Wide-field fundus photograph from neonatal ROP screening:
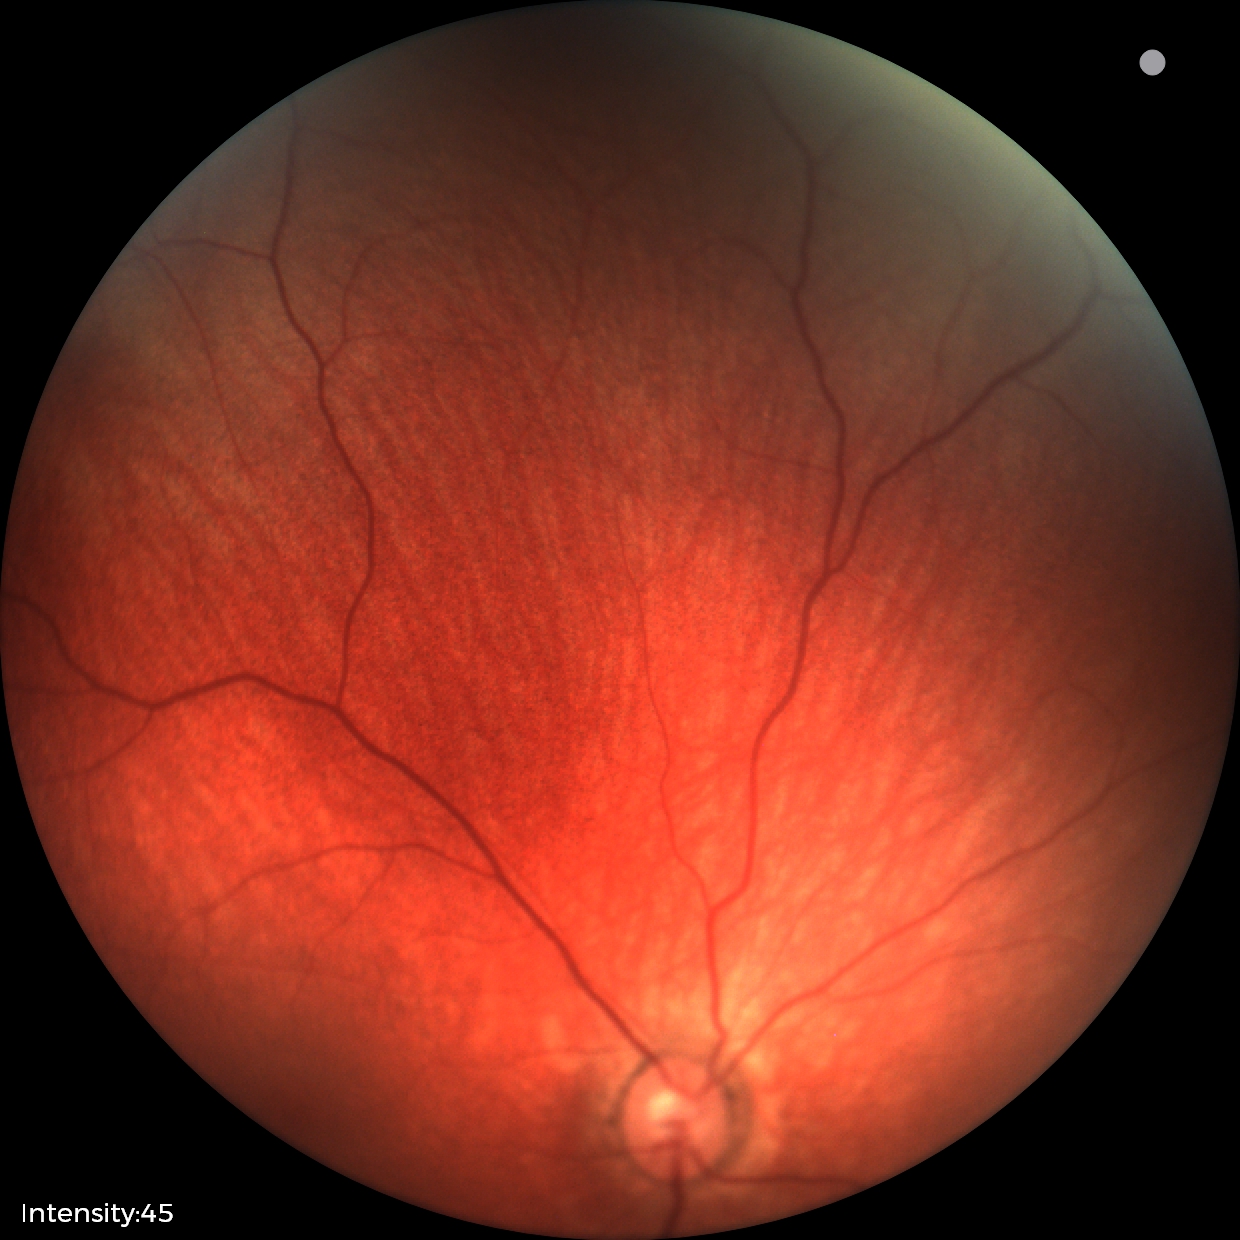 Screening examination diagnosed as physiological.